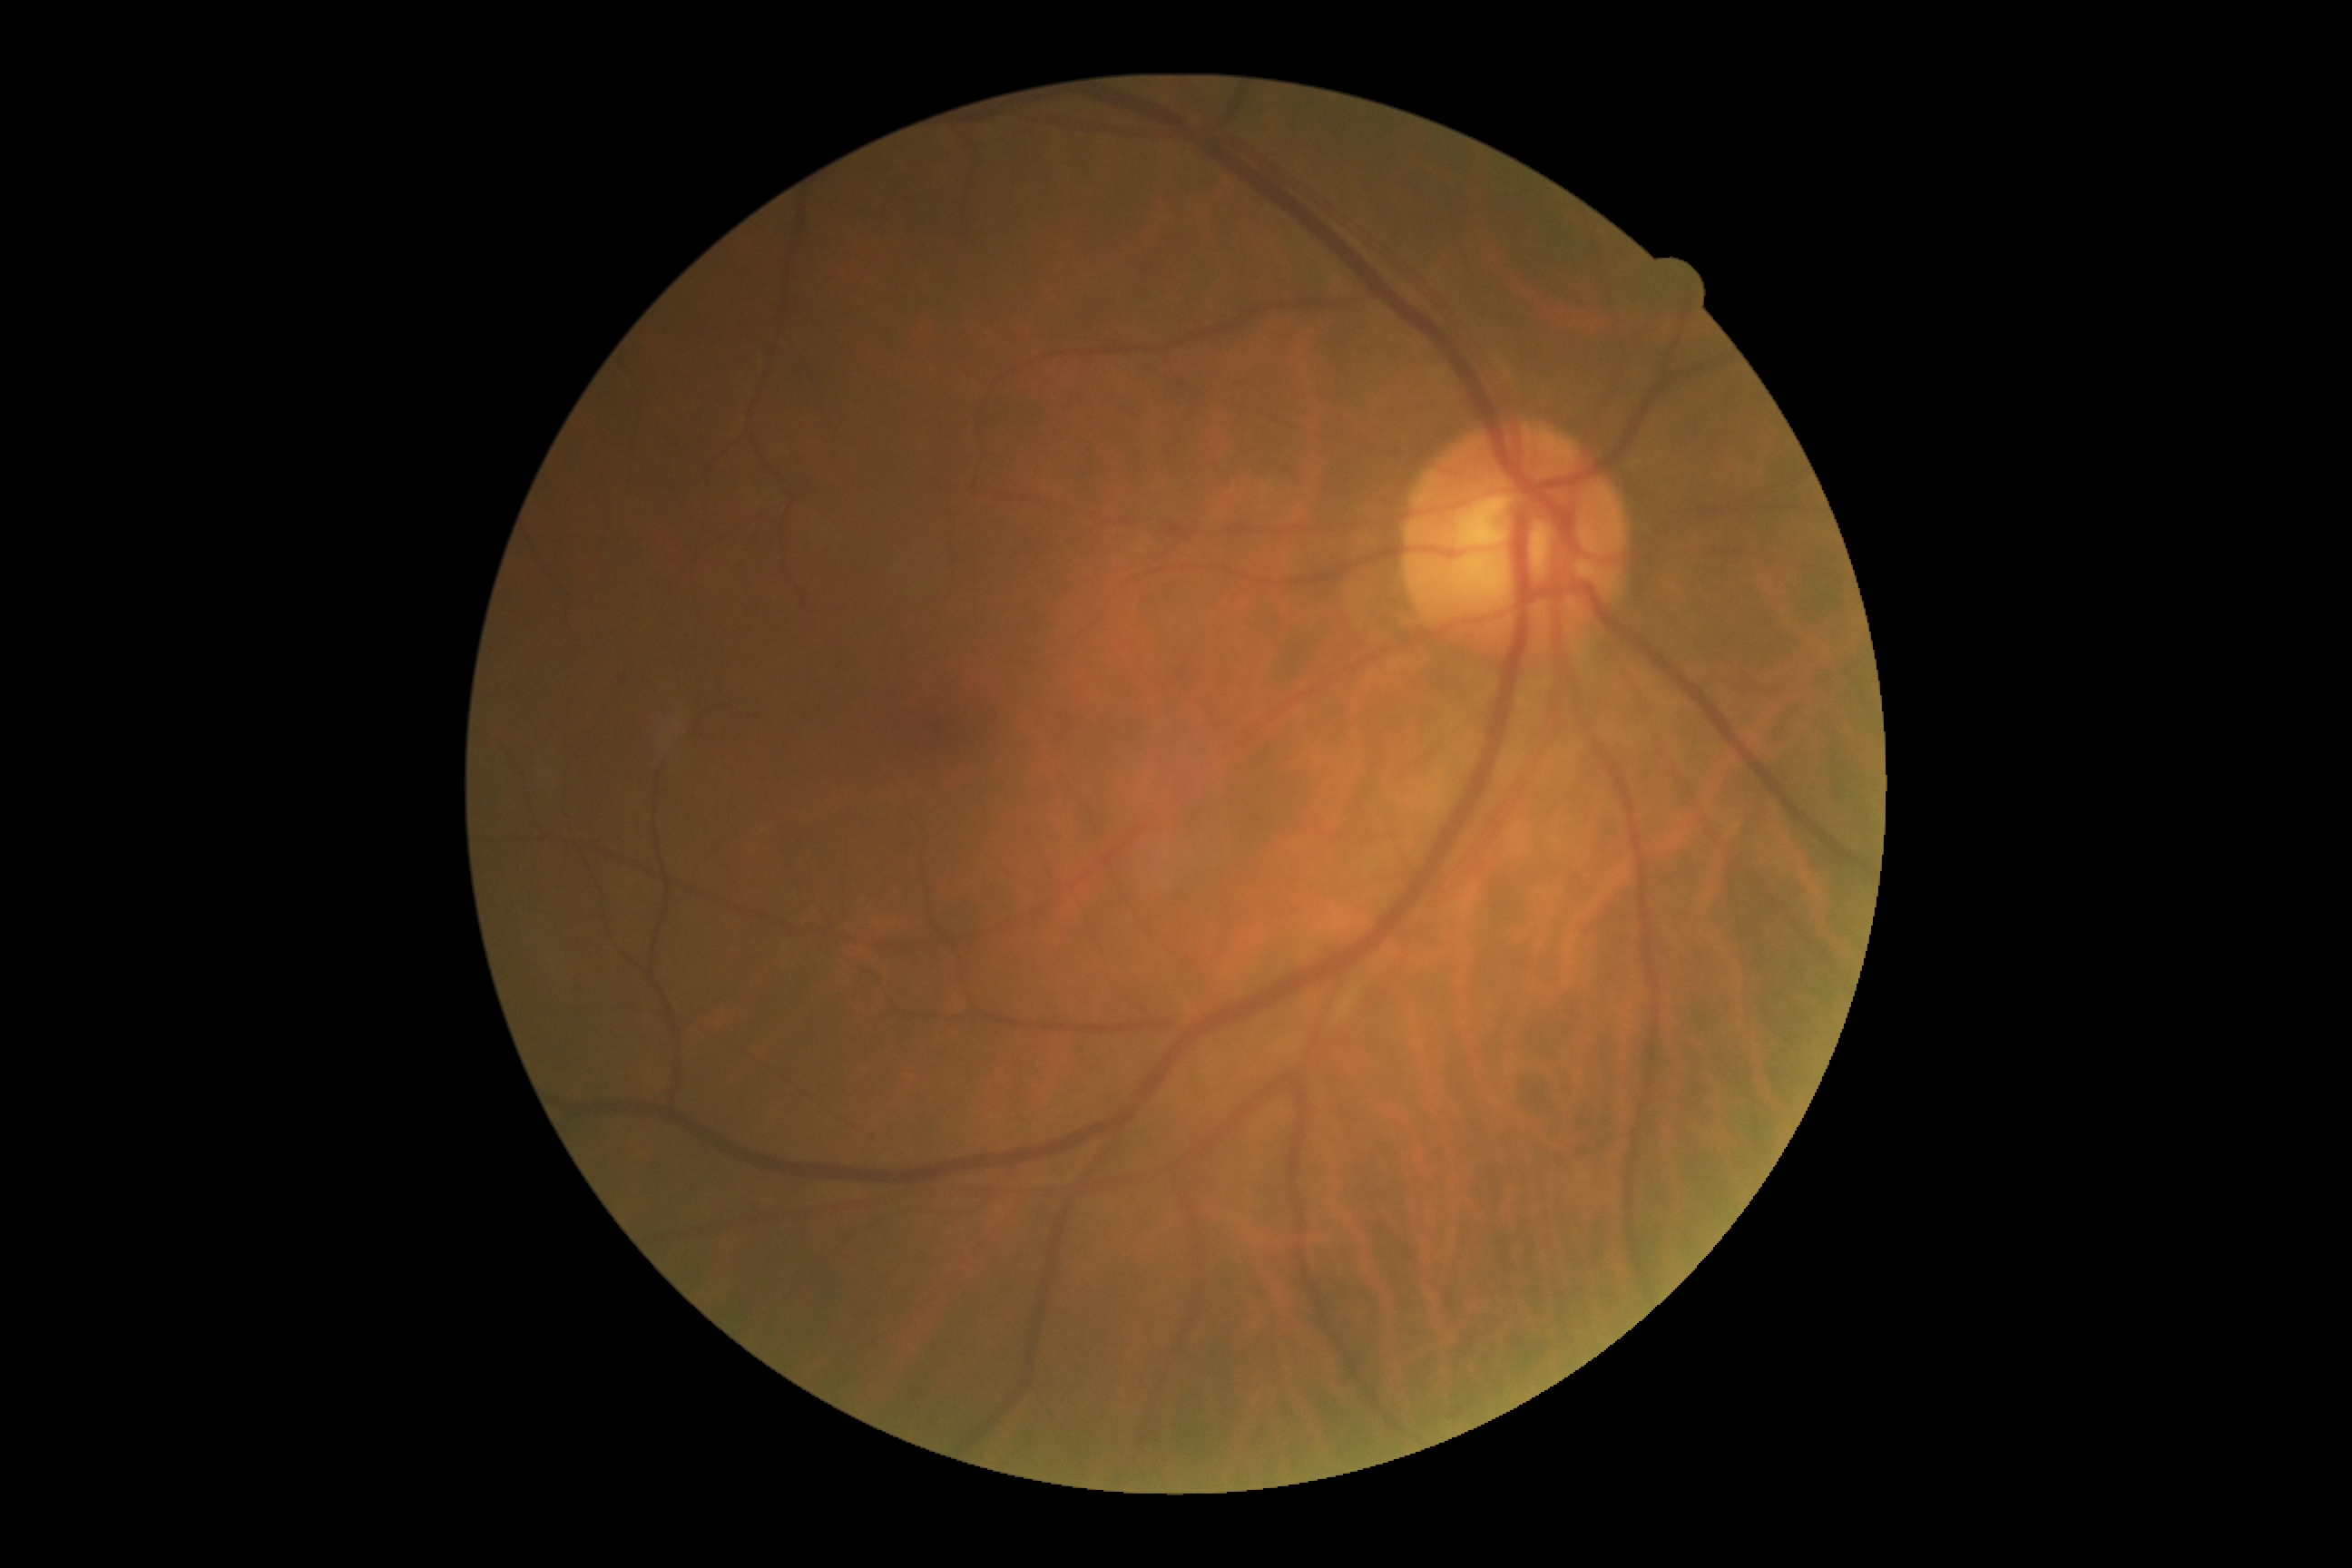

No diabetic retinal disease findings. DR stage is no apparent diabetic retinopathy (grade 0).